2212x1659 · fundus photo taken with a portable handheld camera · 60° field of view
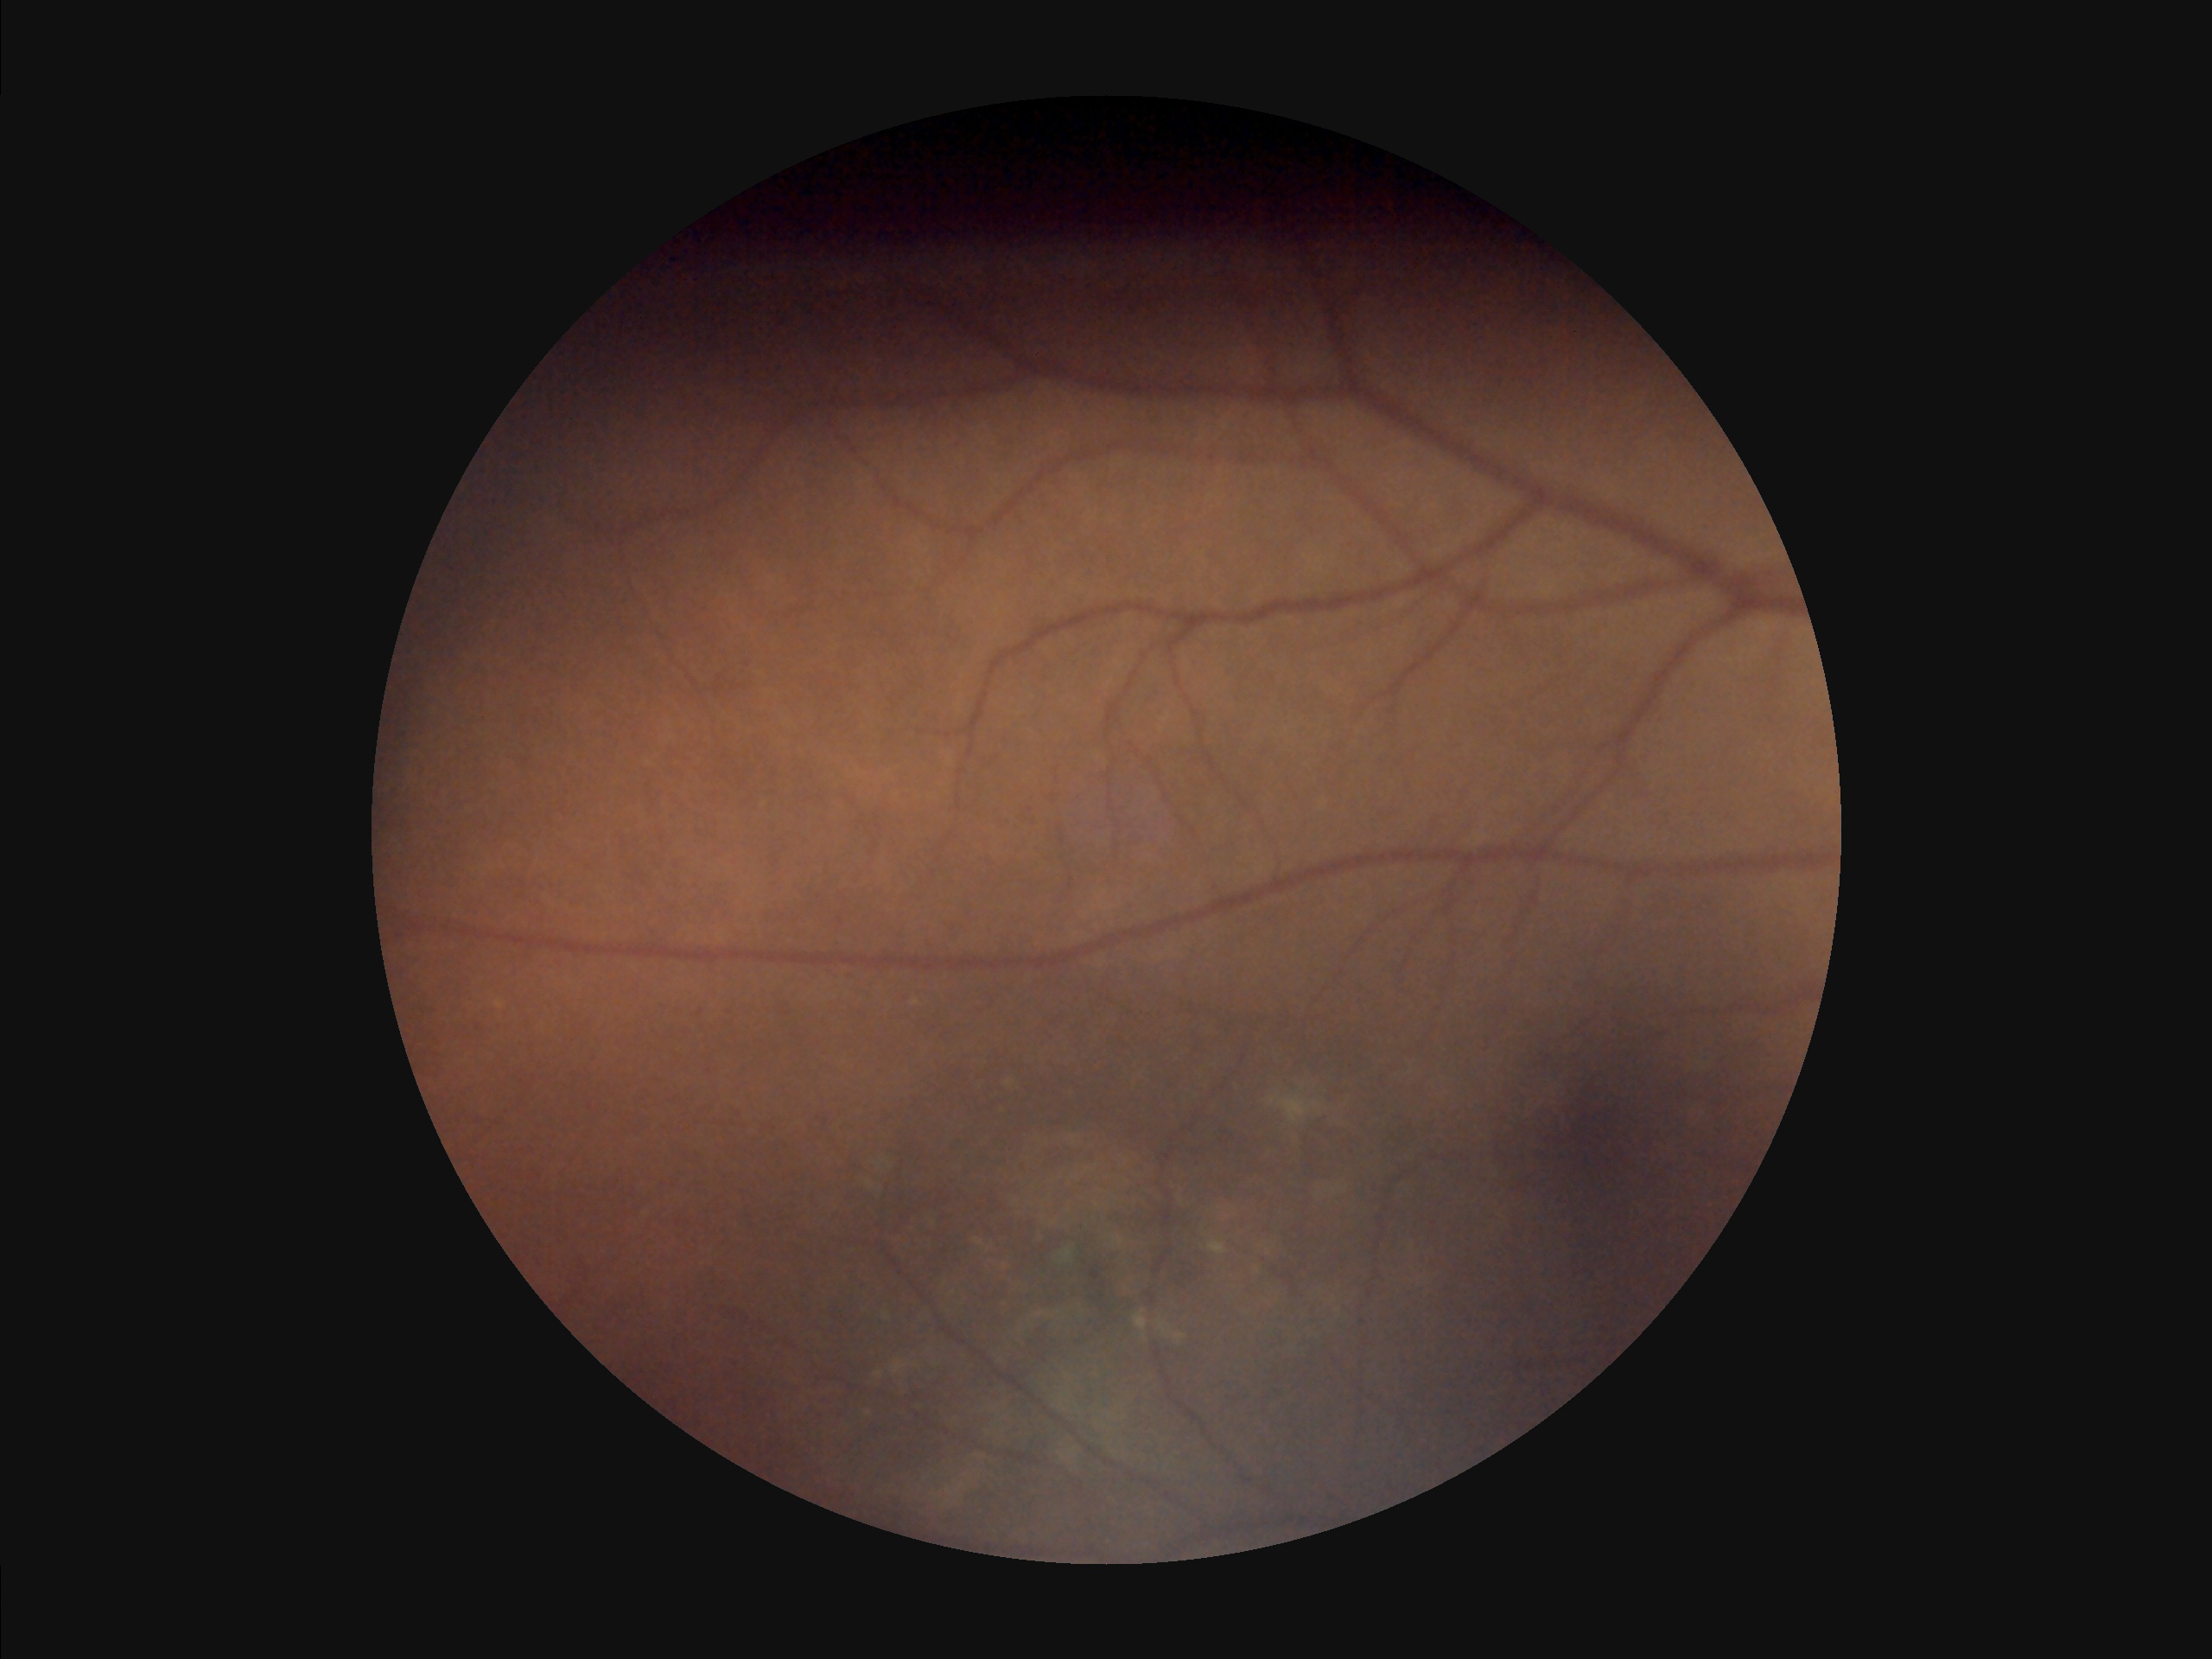 No noticeable blur. Illumination is uneven. Poor dynamic range. Image quality is inadequate for diagnostic use.